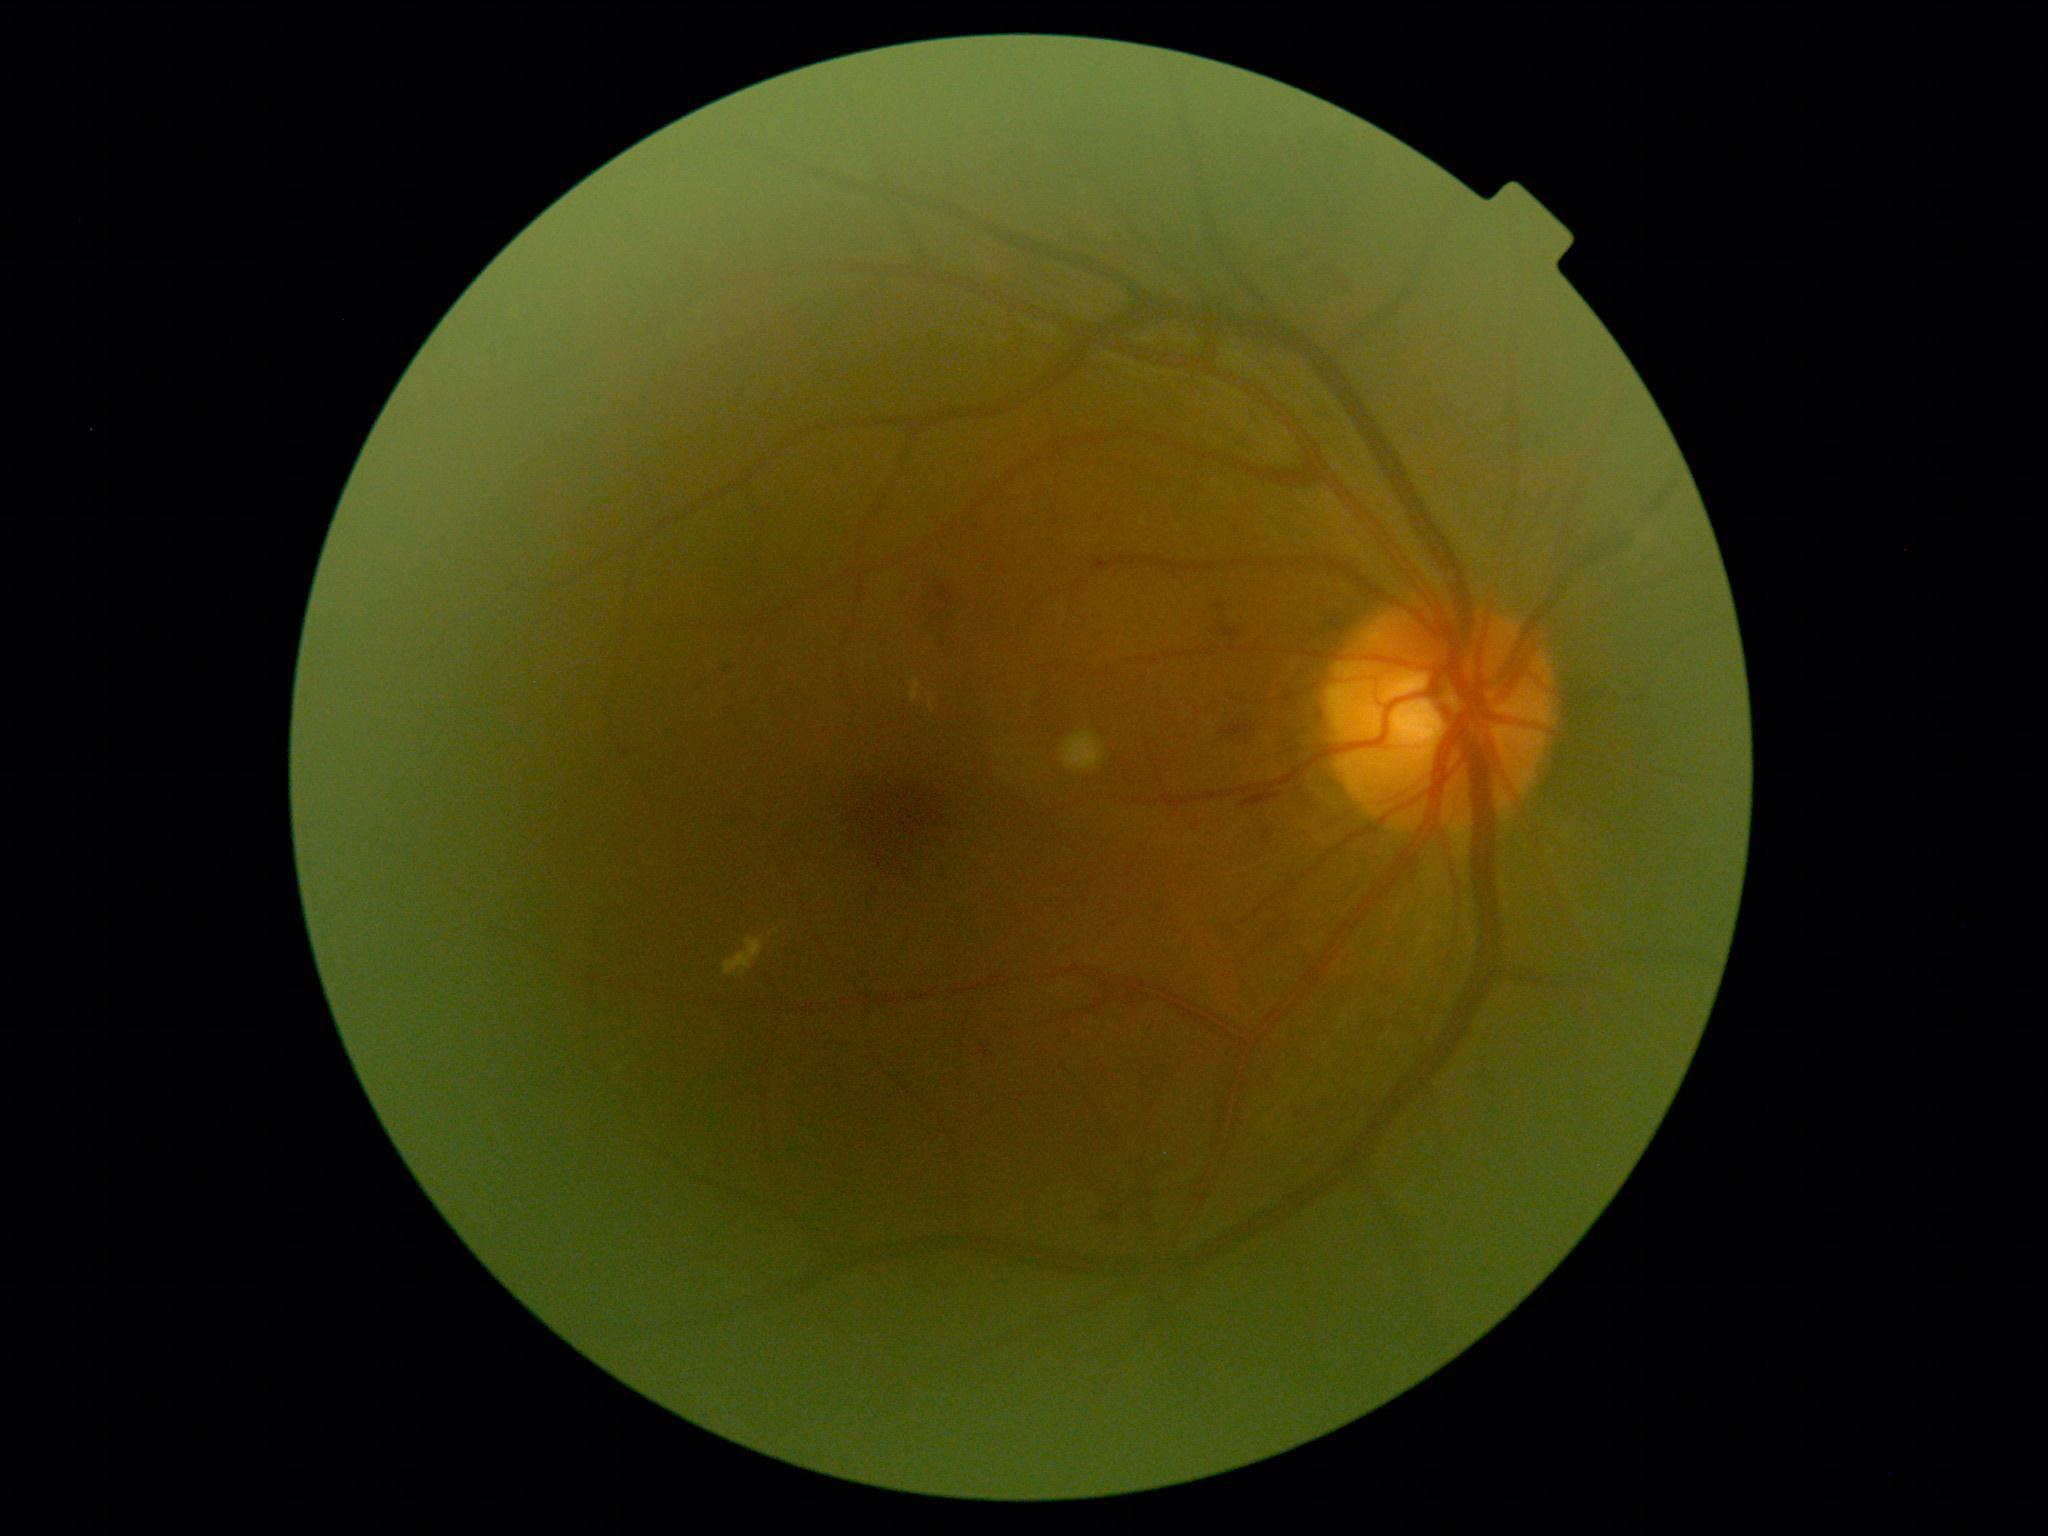

retinopathy grade = 2.